Color fundus photograph.
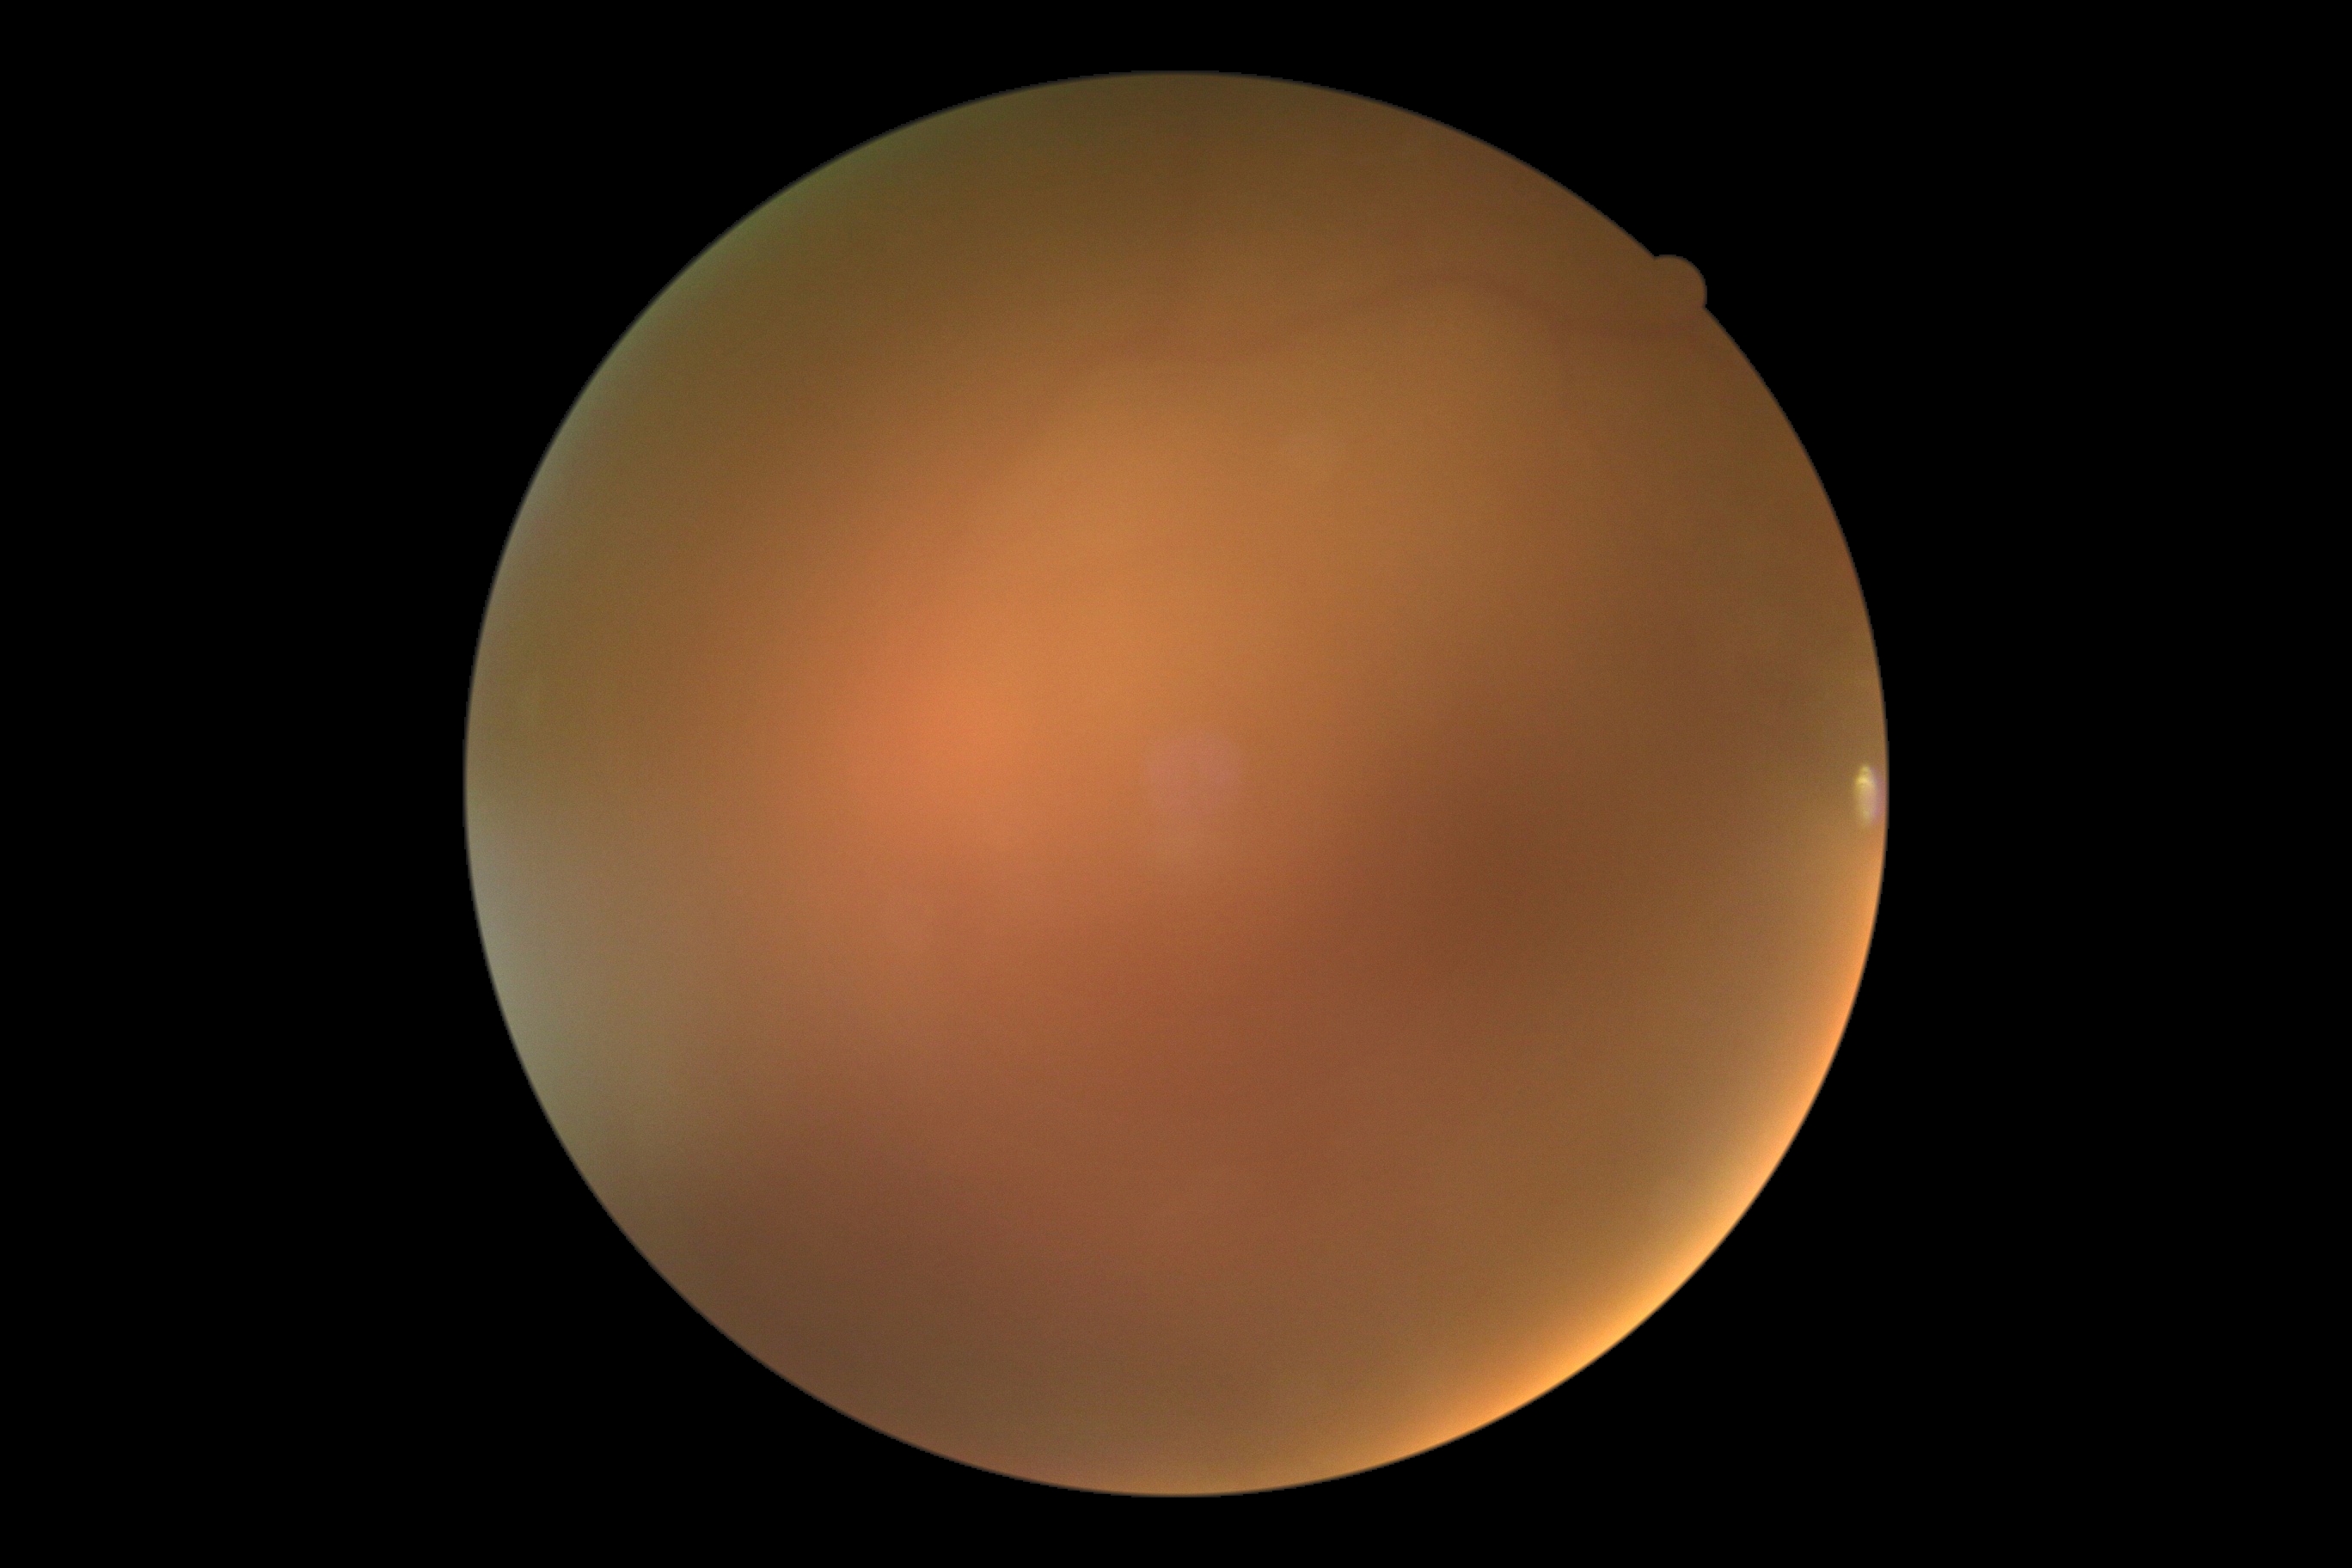 - image quality — insufficient for DR assessment
- diabetic retinopathy (DR) — ungradable due to poor image quality